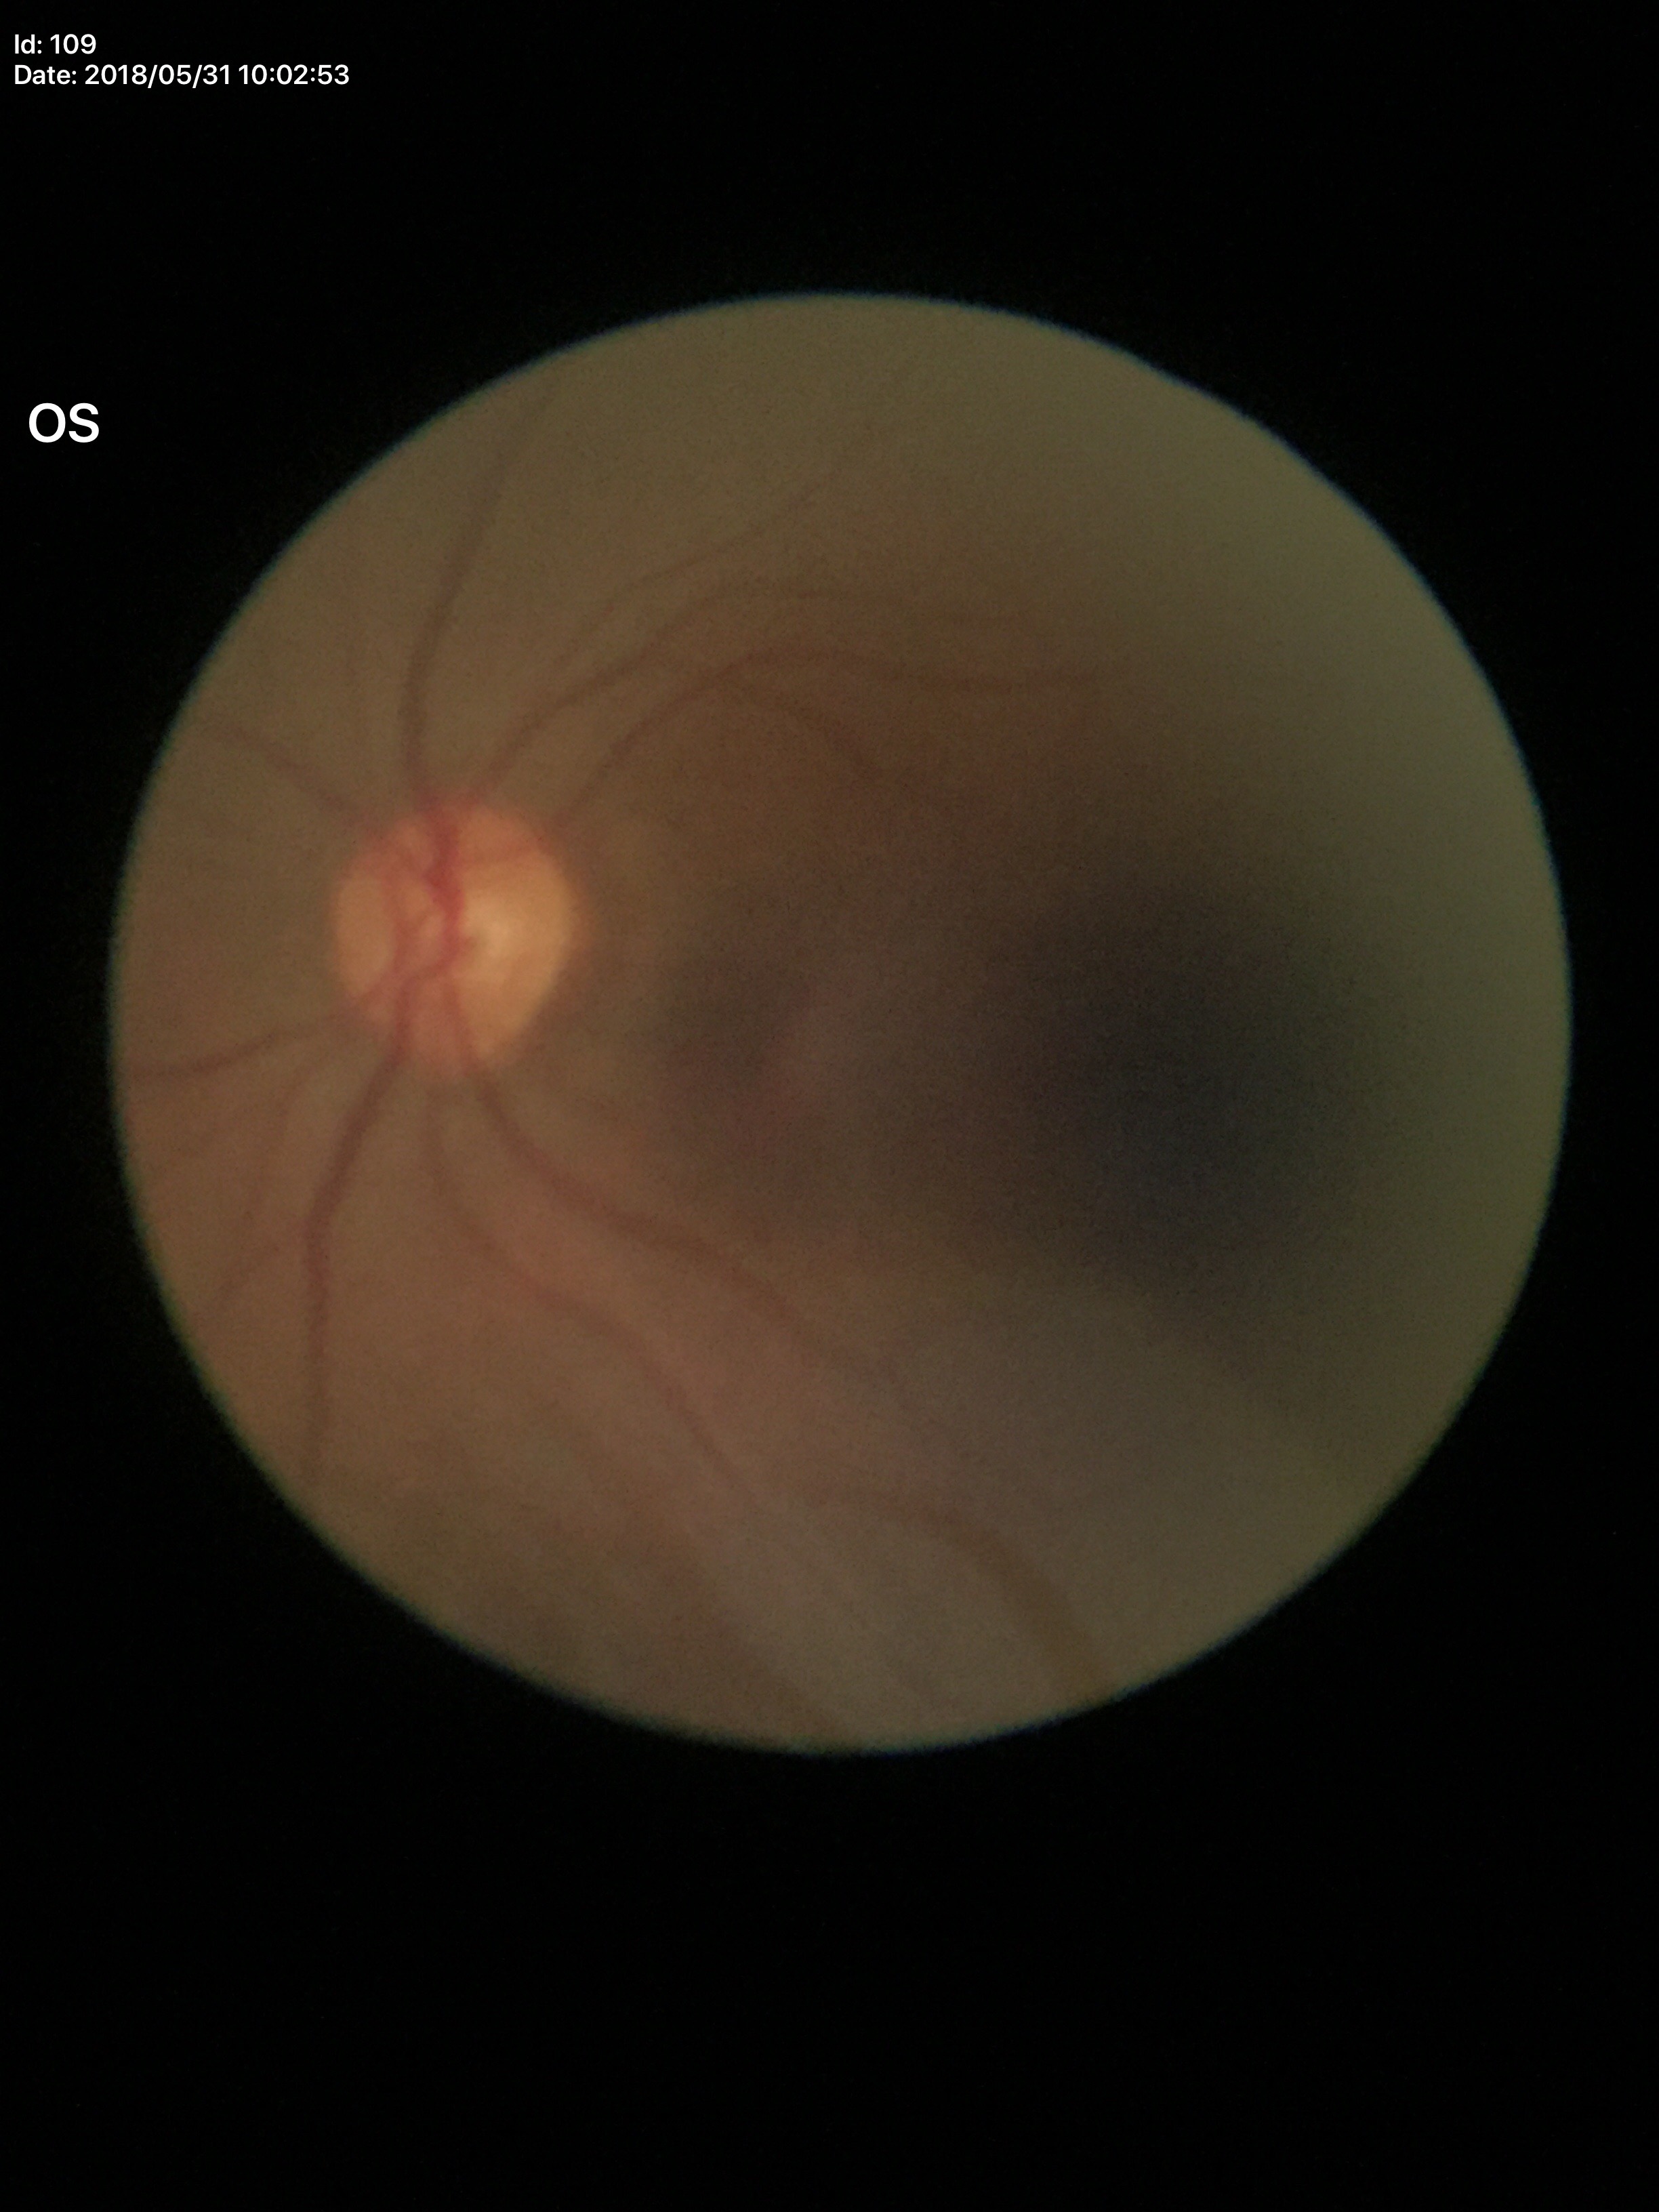

Glaucoma screening impression: not suspect (all 5 graders called normal); vertical cup-disc ratio: 0.48; horizontal C/D ratio: 0.50.